Wide-field fundus photograph from neonatal ROP screening.
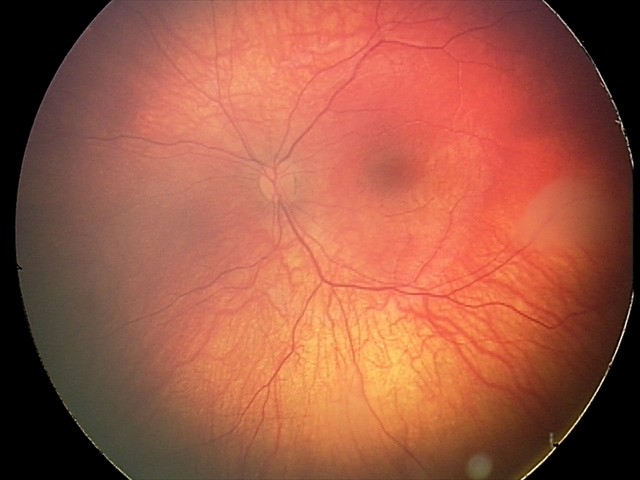
Screening examination consistent with retinal astrocytic hamartoma.